Captured on a Topcon TRC-50DX fundus camera · 50° FOV · posterior pole field covering the optic disc and macula · fundus photo — 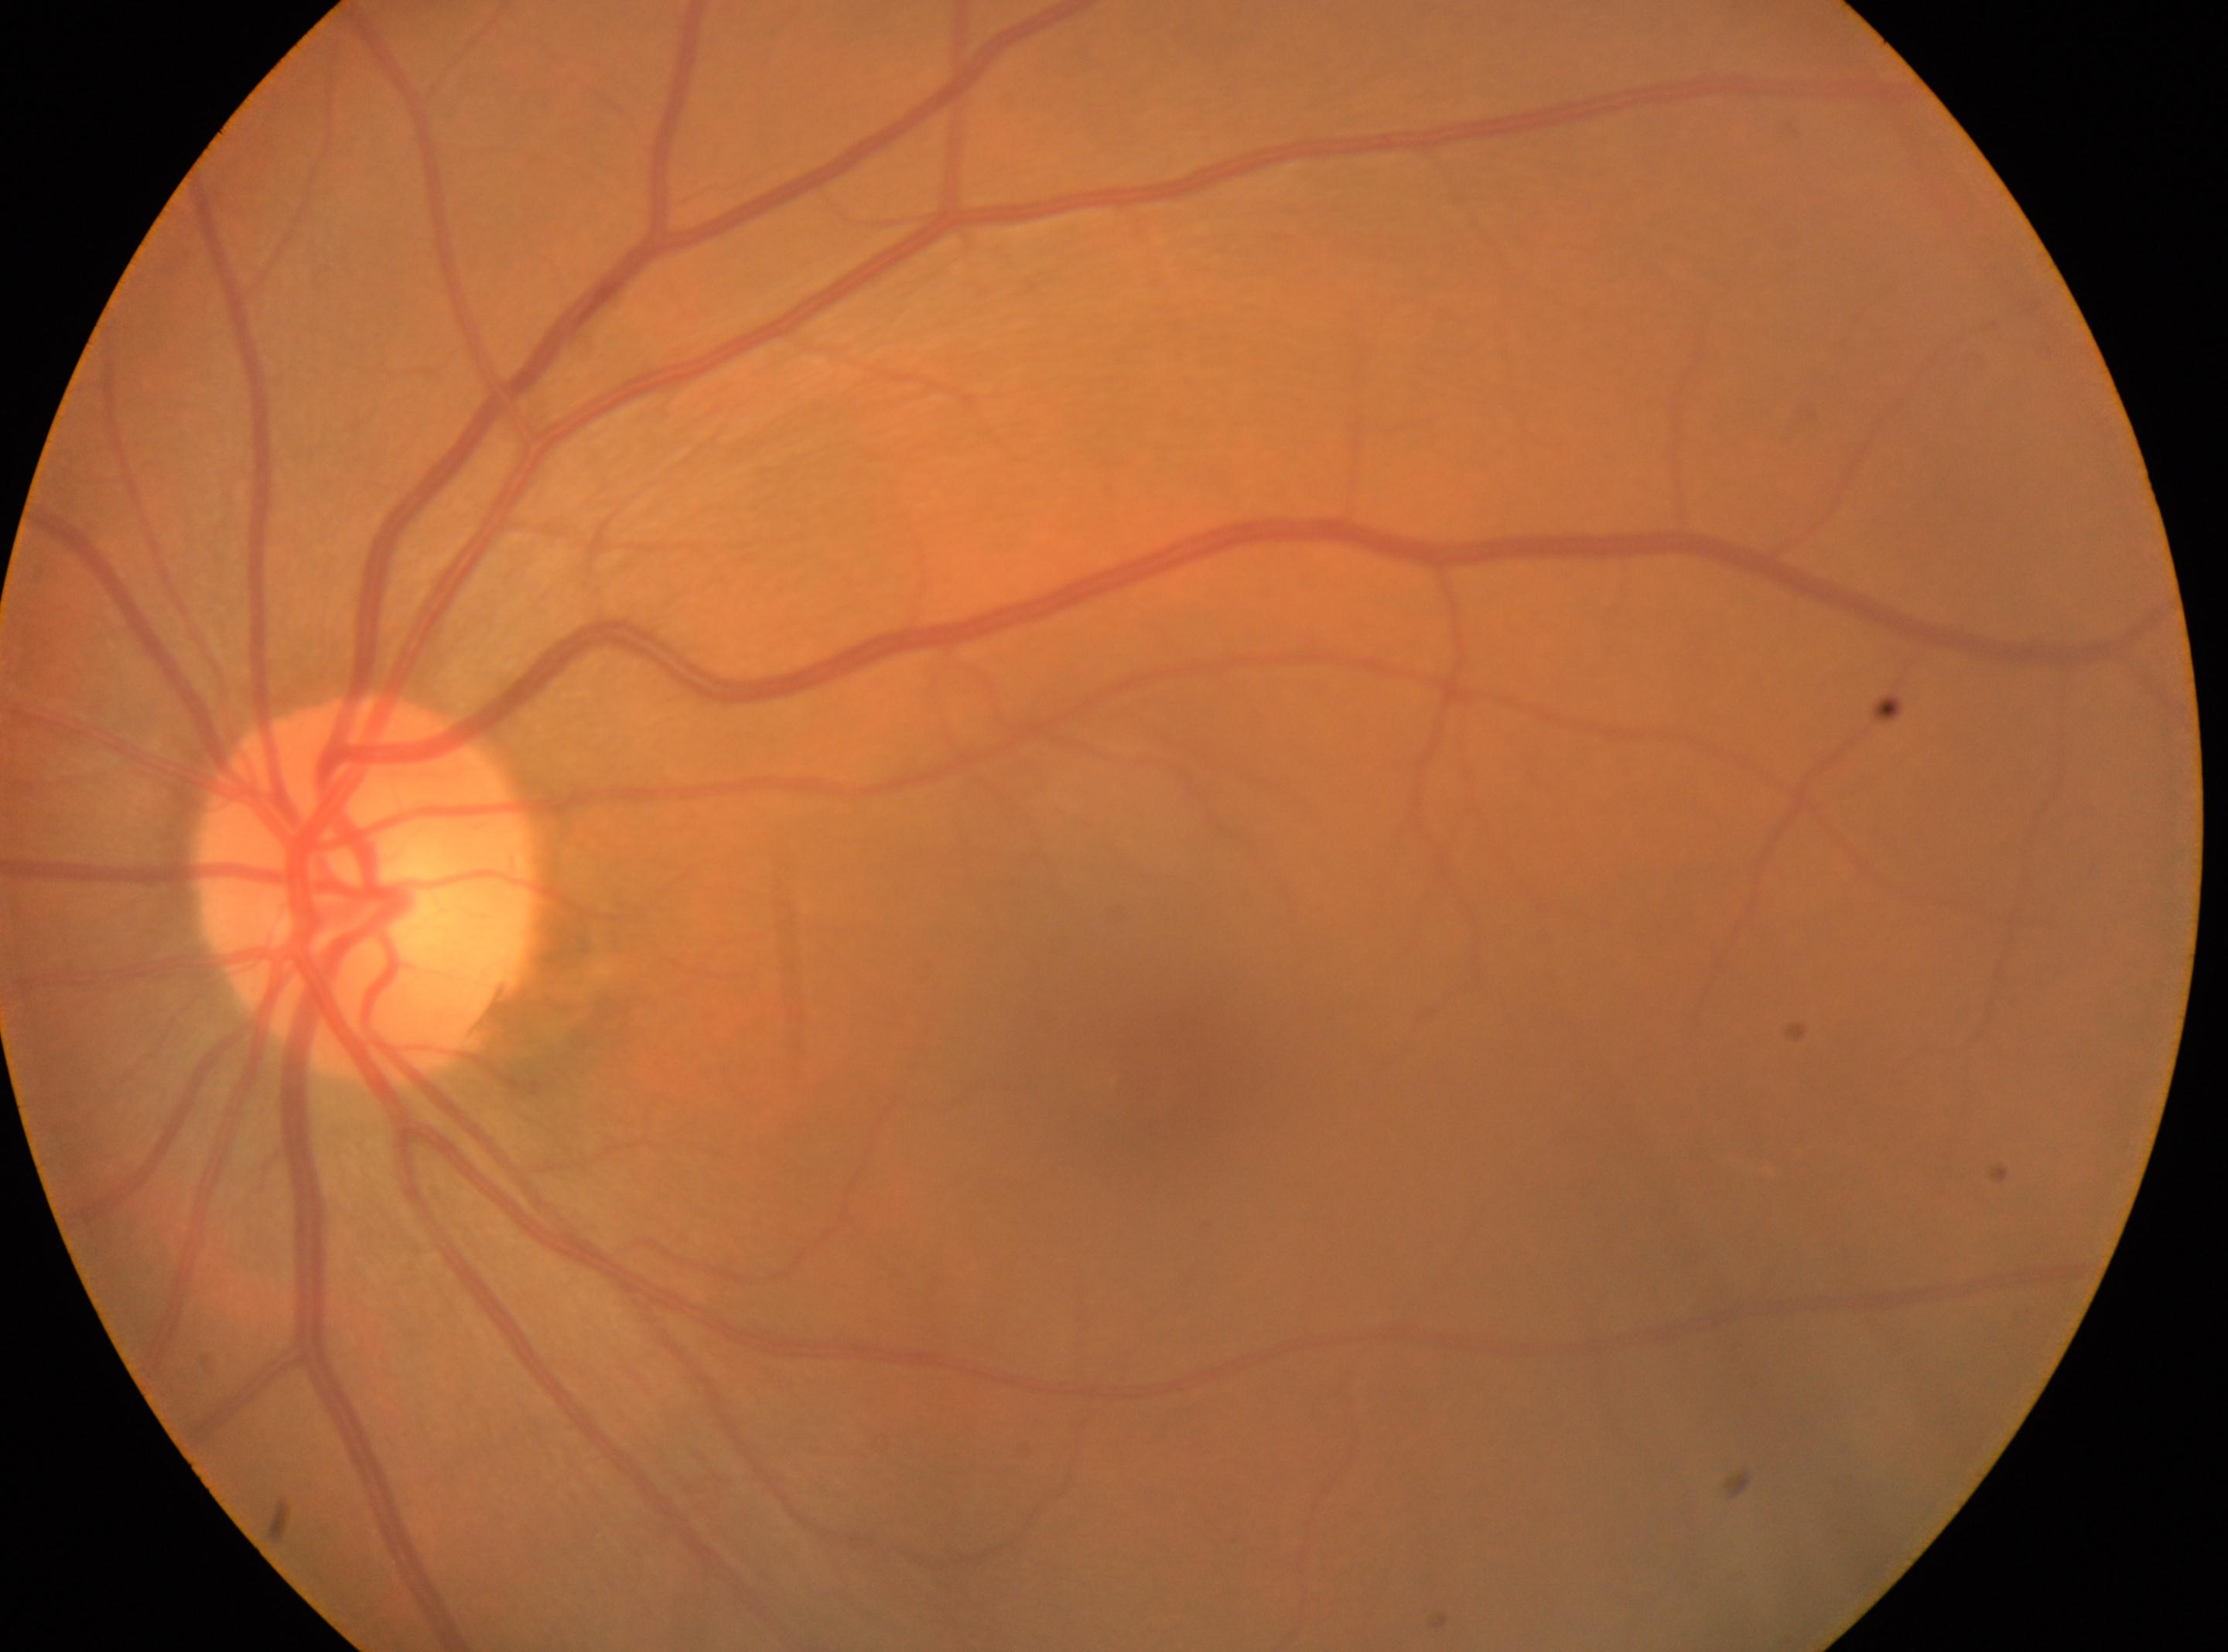
Optic disc: (364, 889). DR stage: 0/4 — no visible signs of diabetic retinopathy. This is the OS. The fovea centralis is at (1142, 1077).